2048 by 1536 pixels, FOV: 45 degrees.
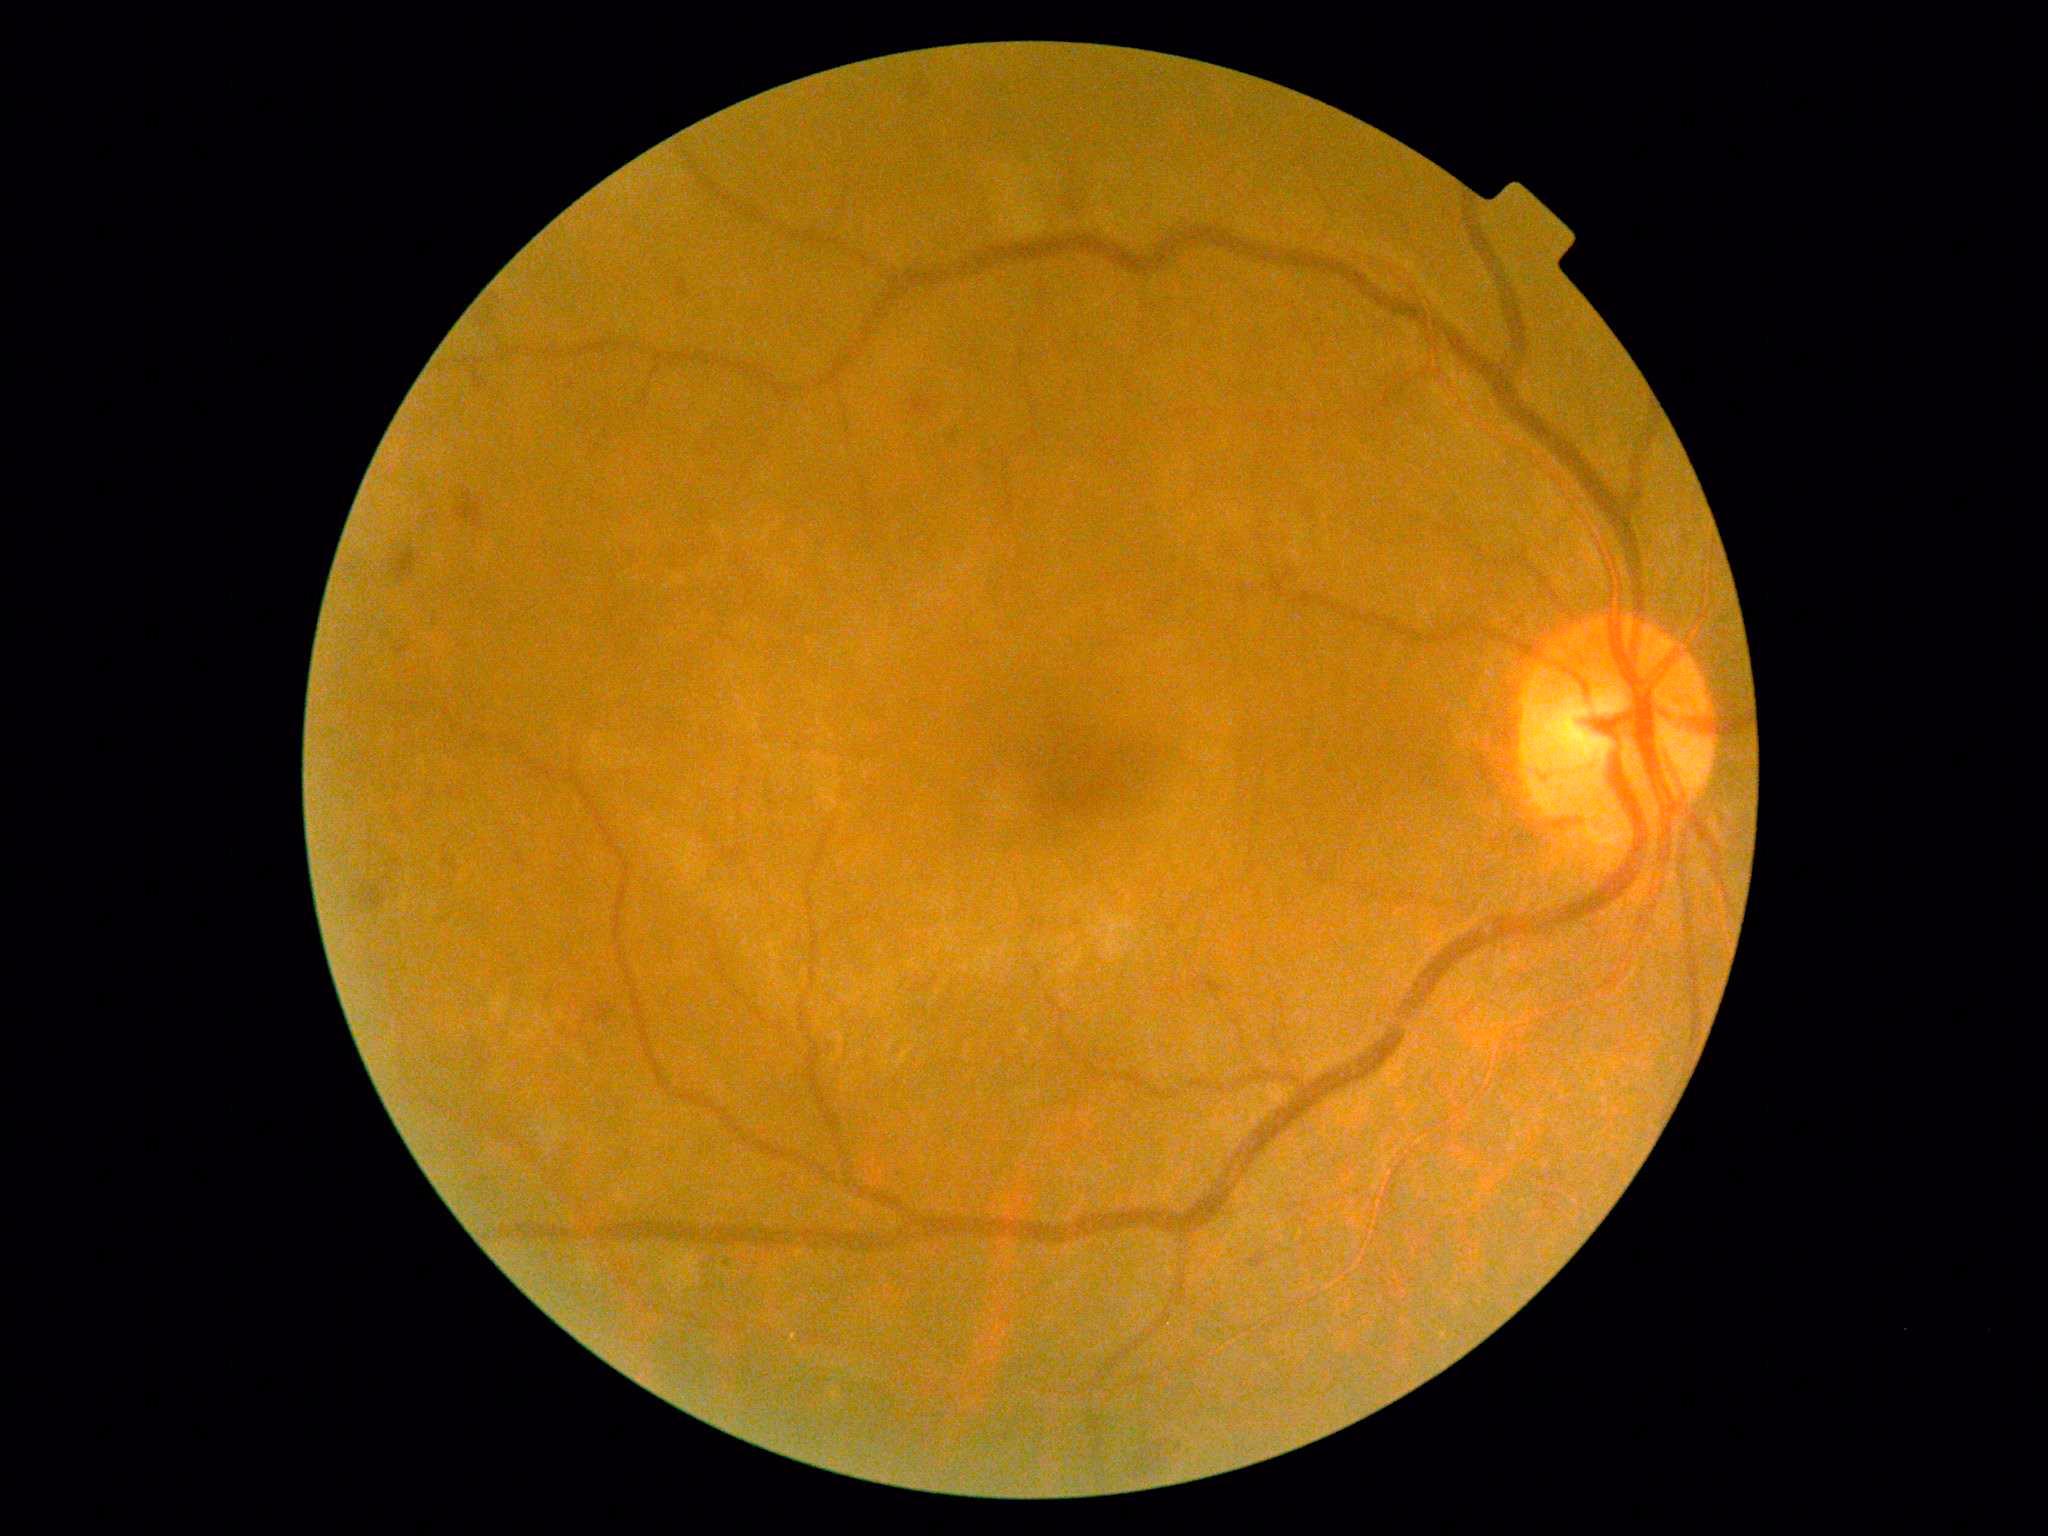 DR: moderate non-proliferative diabetic retinopathy (grade 2).